45-degree field of view, color fundus image, image size 2212x1672 — 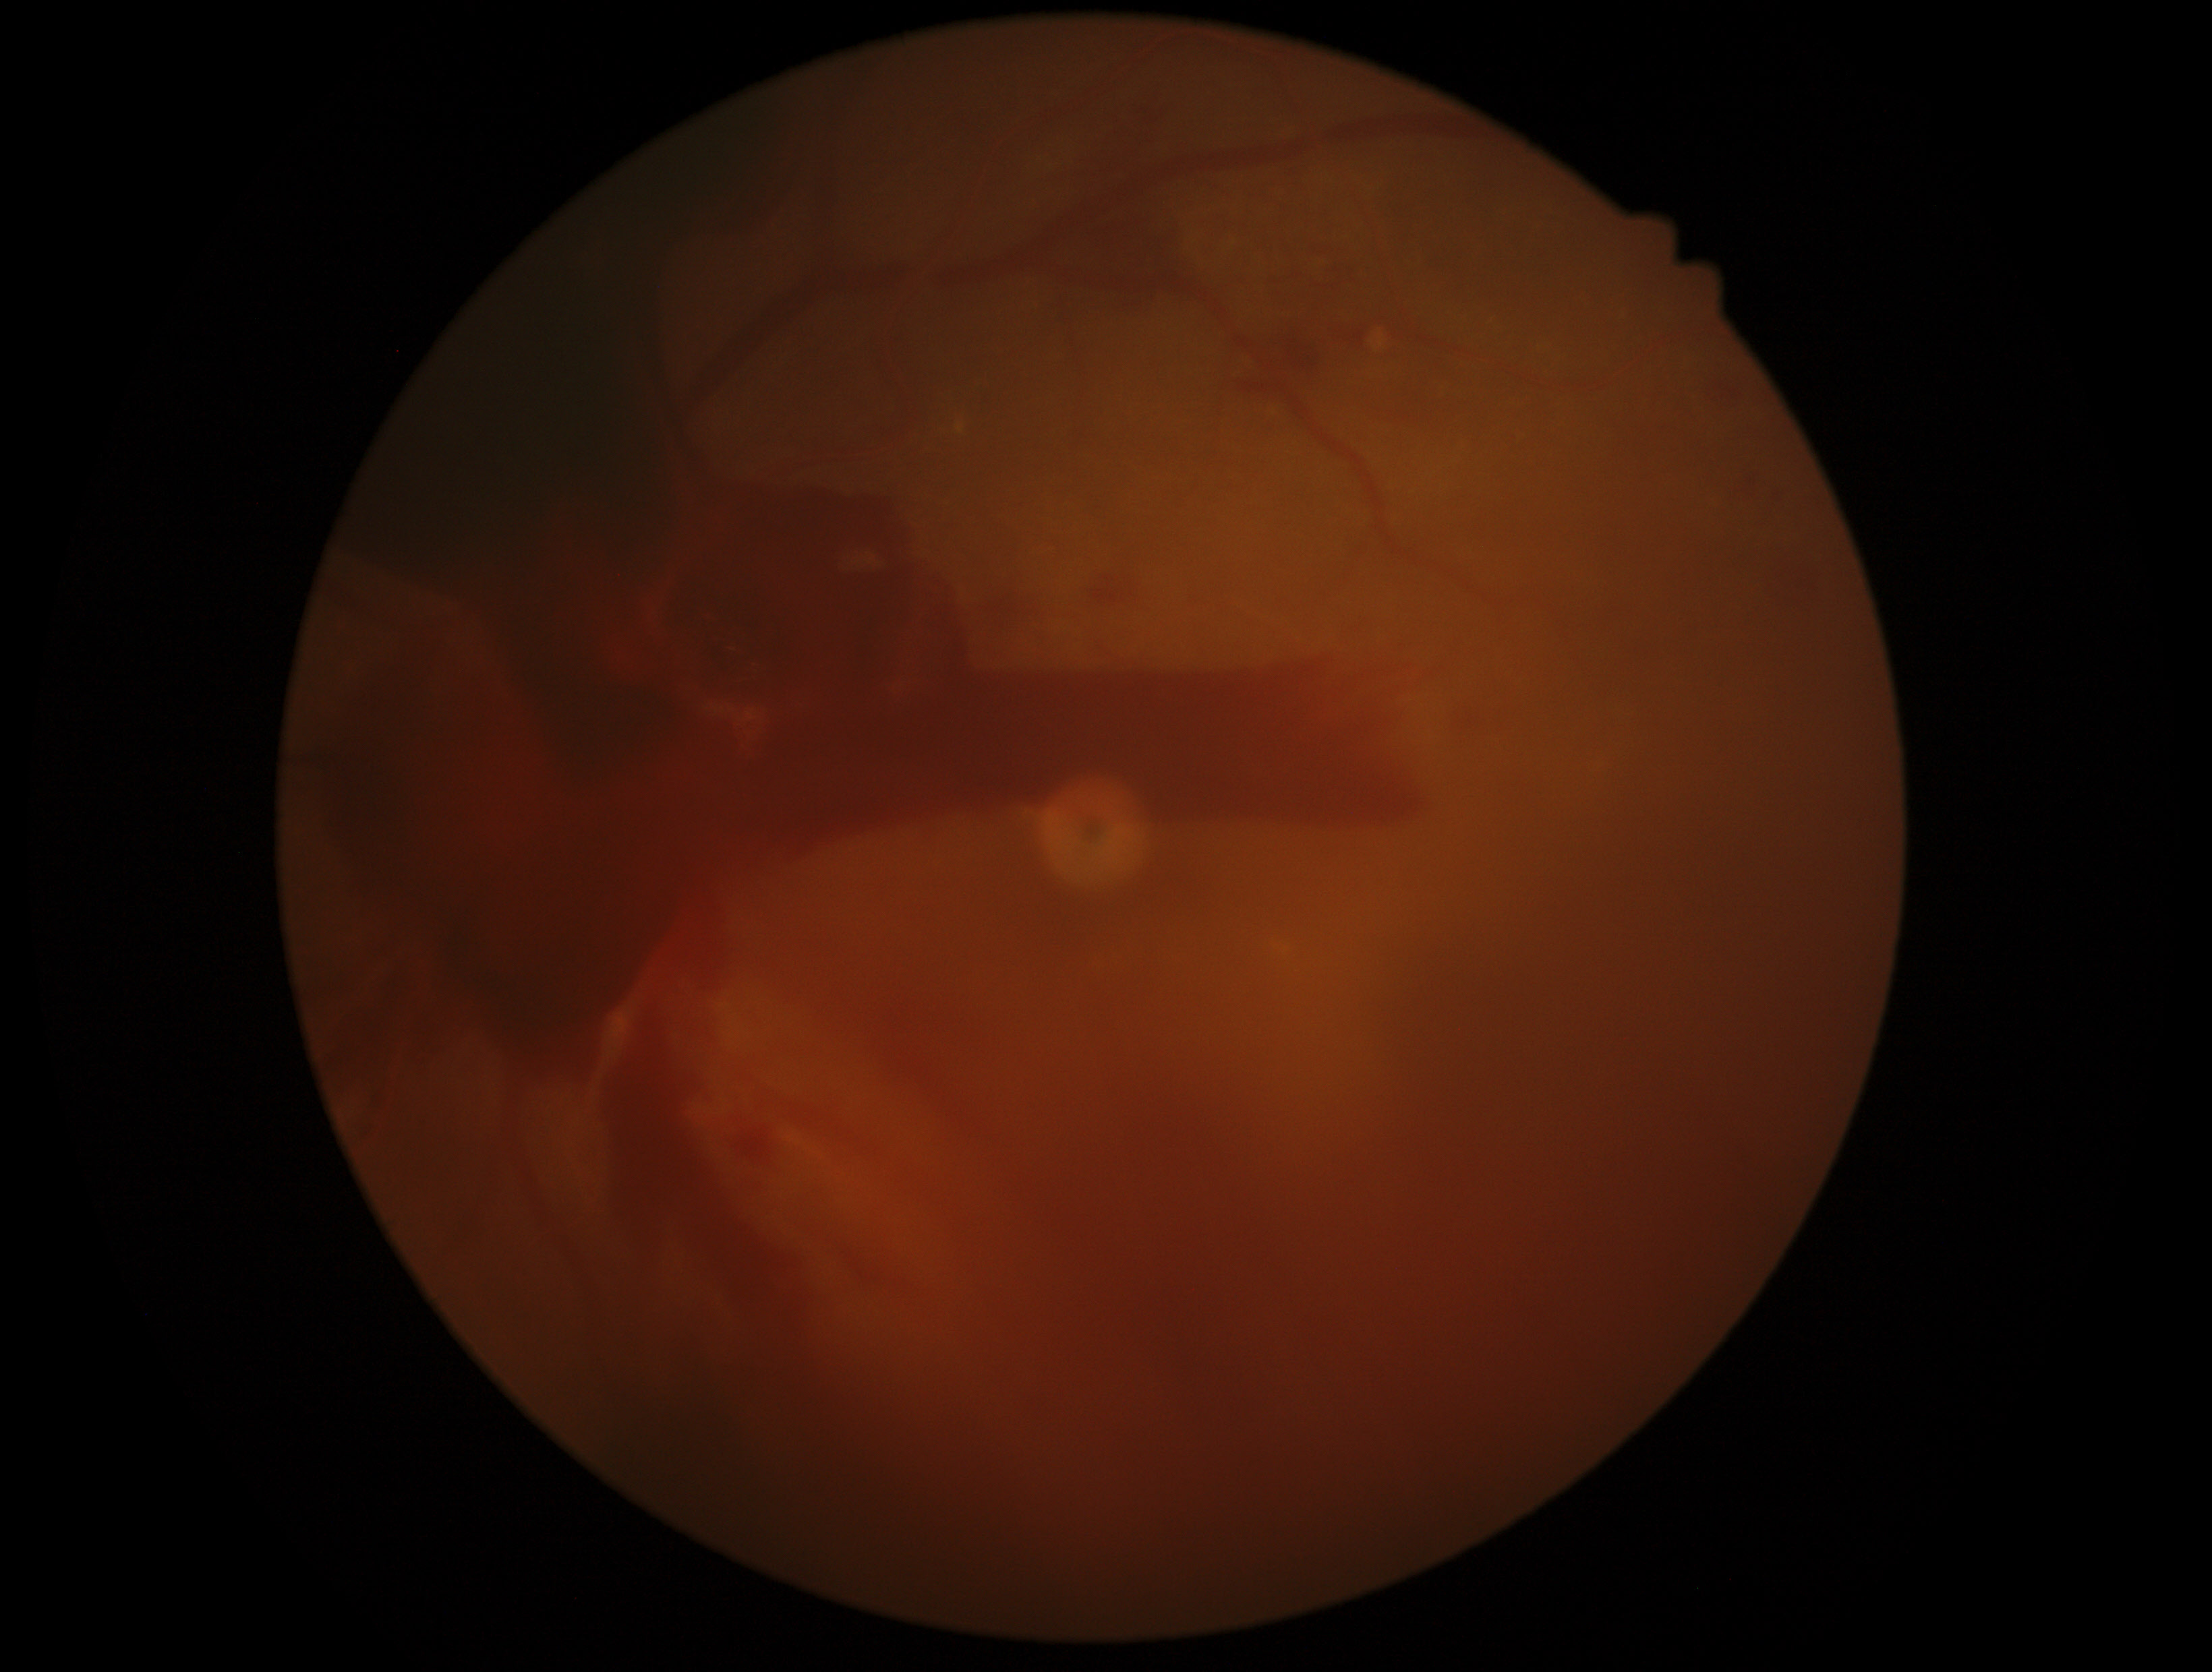
dr_category: proliferative diabetic retinopathy
dr_grade: proliferative diabetic retinopathy (grade 4)